FOV: 45 degrees: 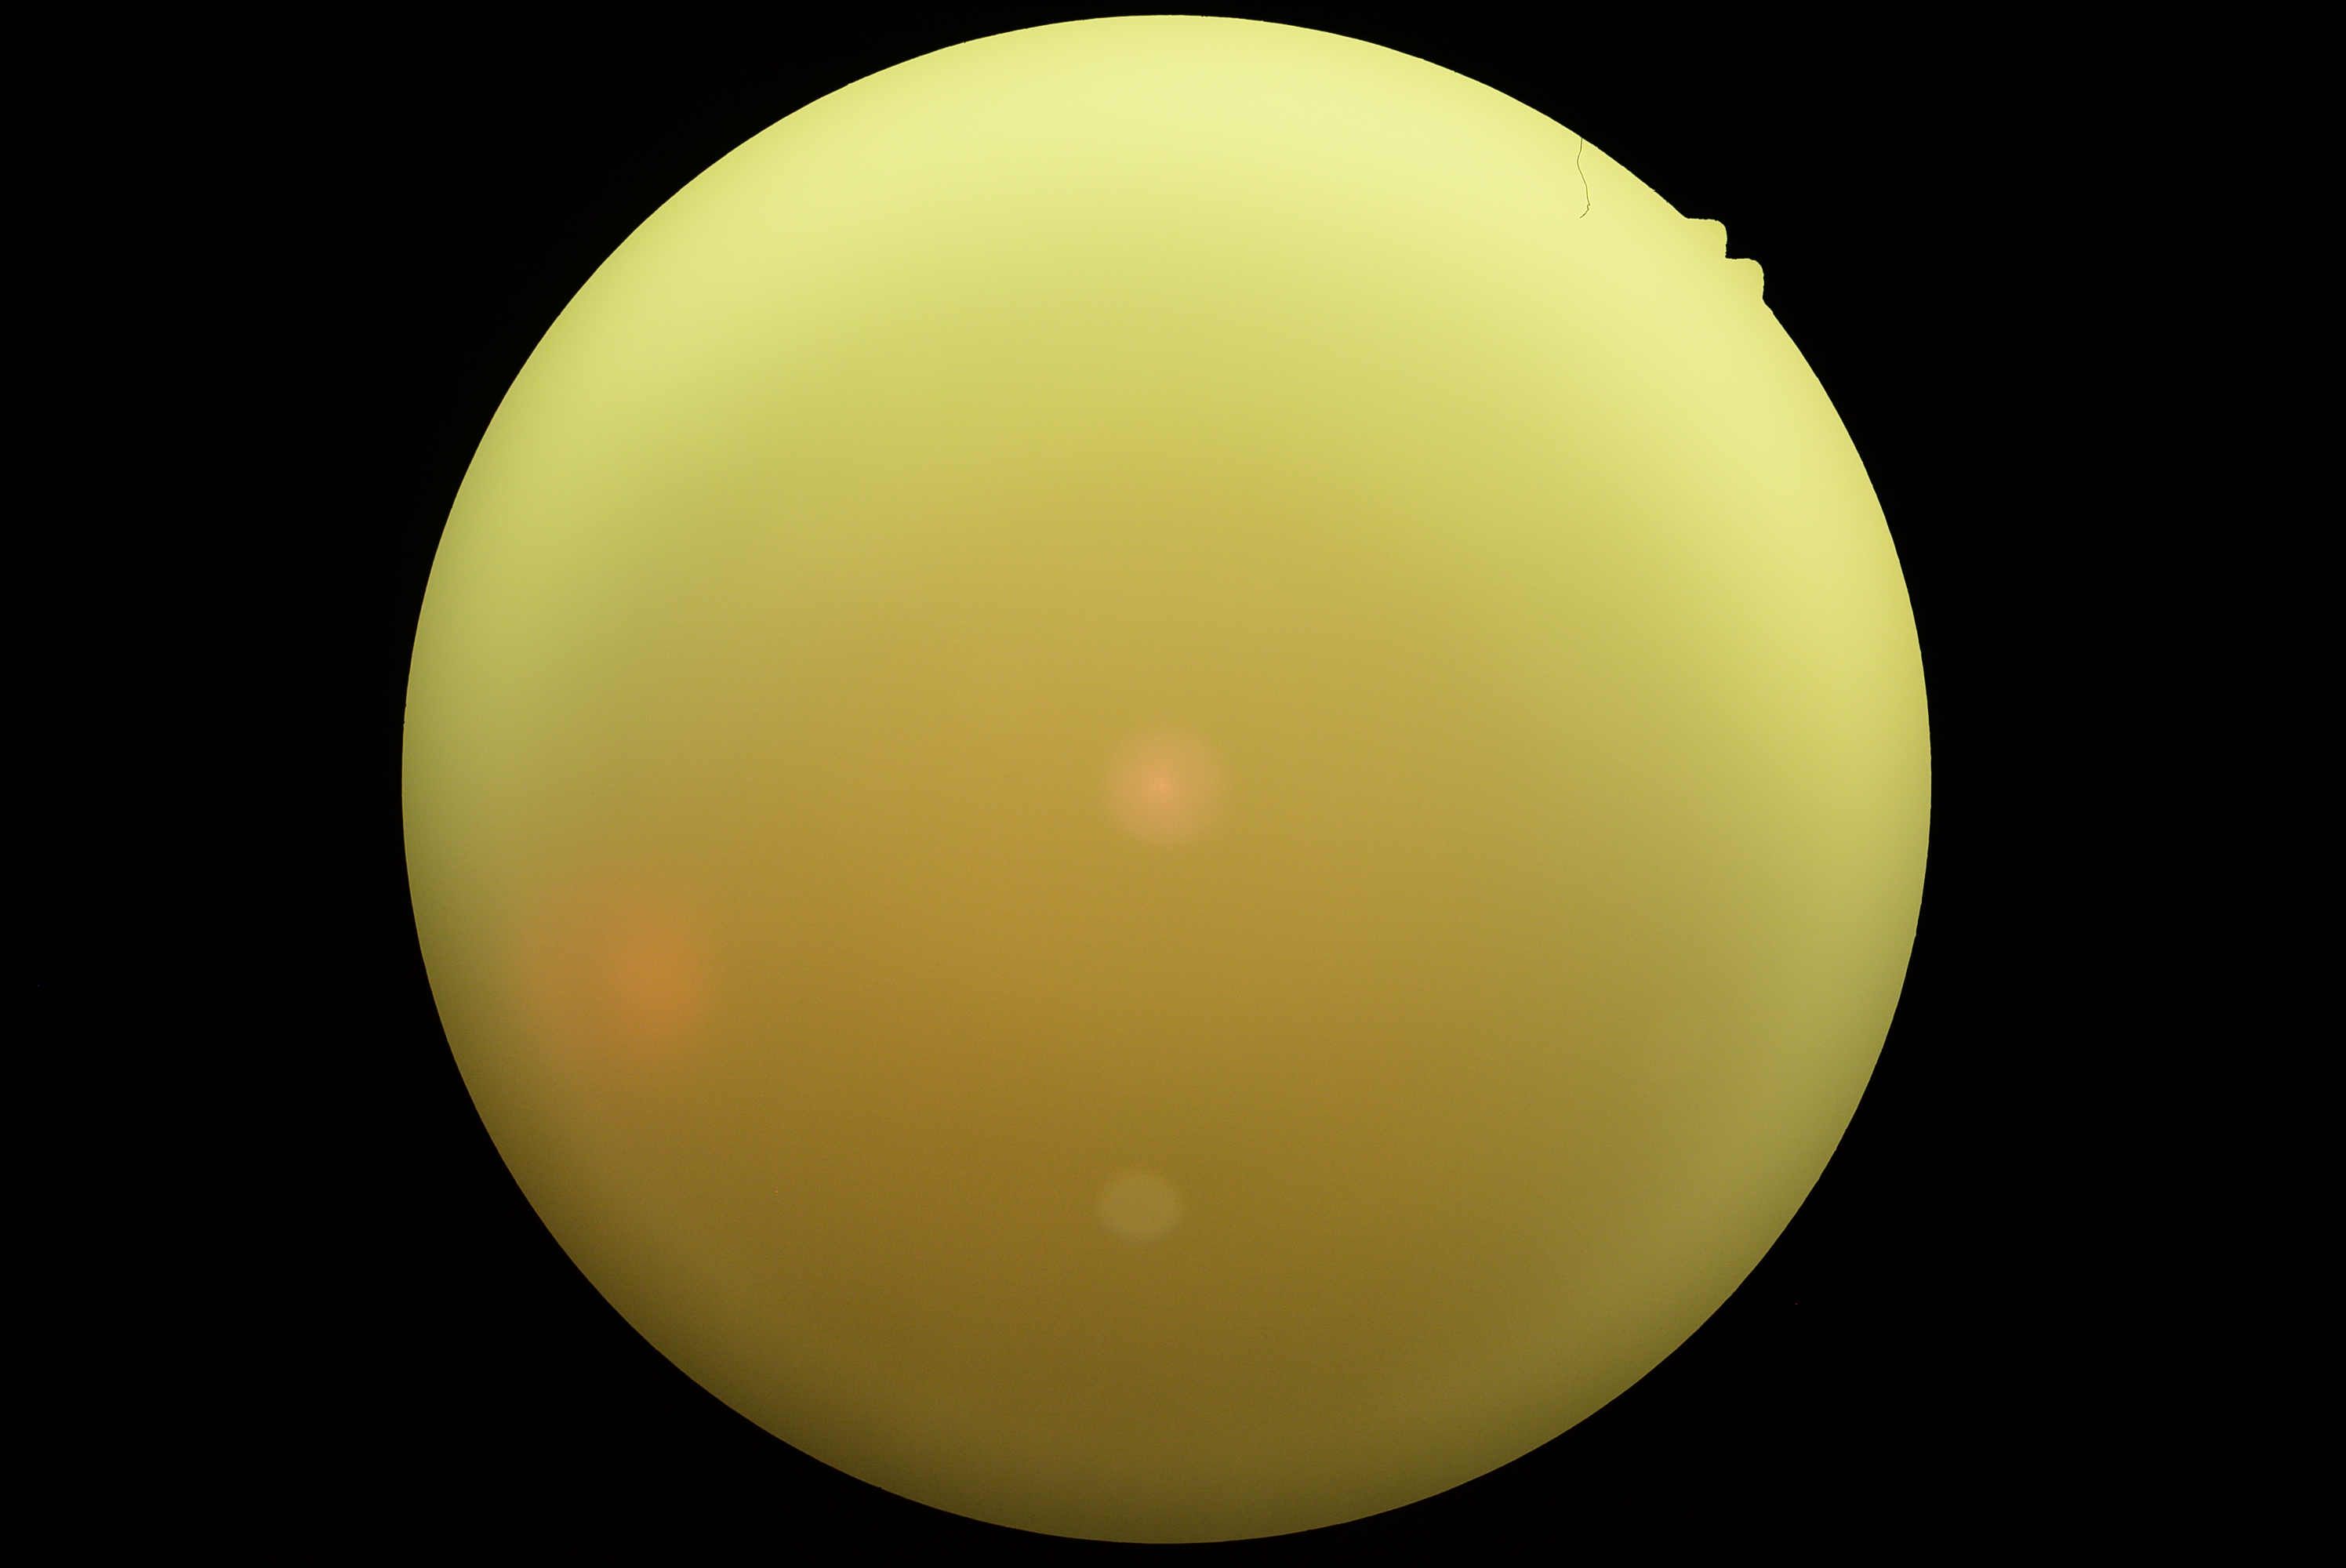 DR grade: ungradable.